Acquired on the Clarity RetCam 3. Pediatric wide-field fundus photograph — 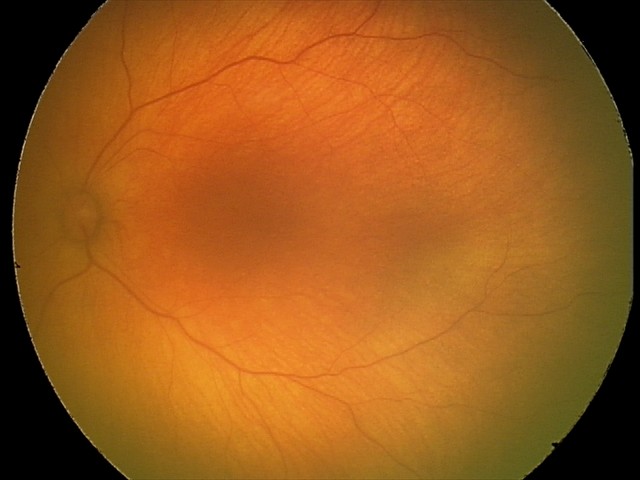
Physiological retinal appearance for postconceptual age.